Image size 2352x1568 — 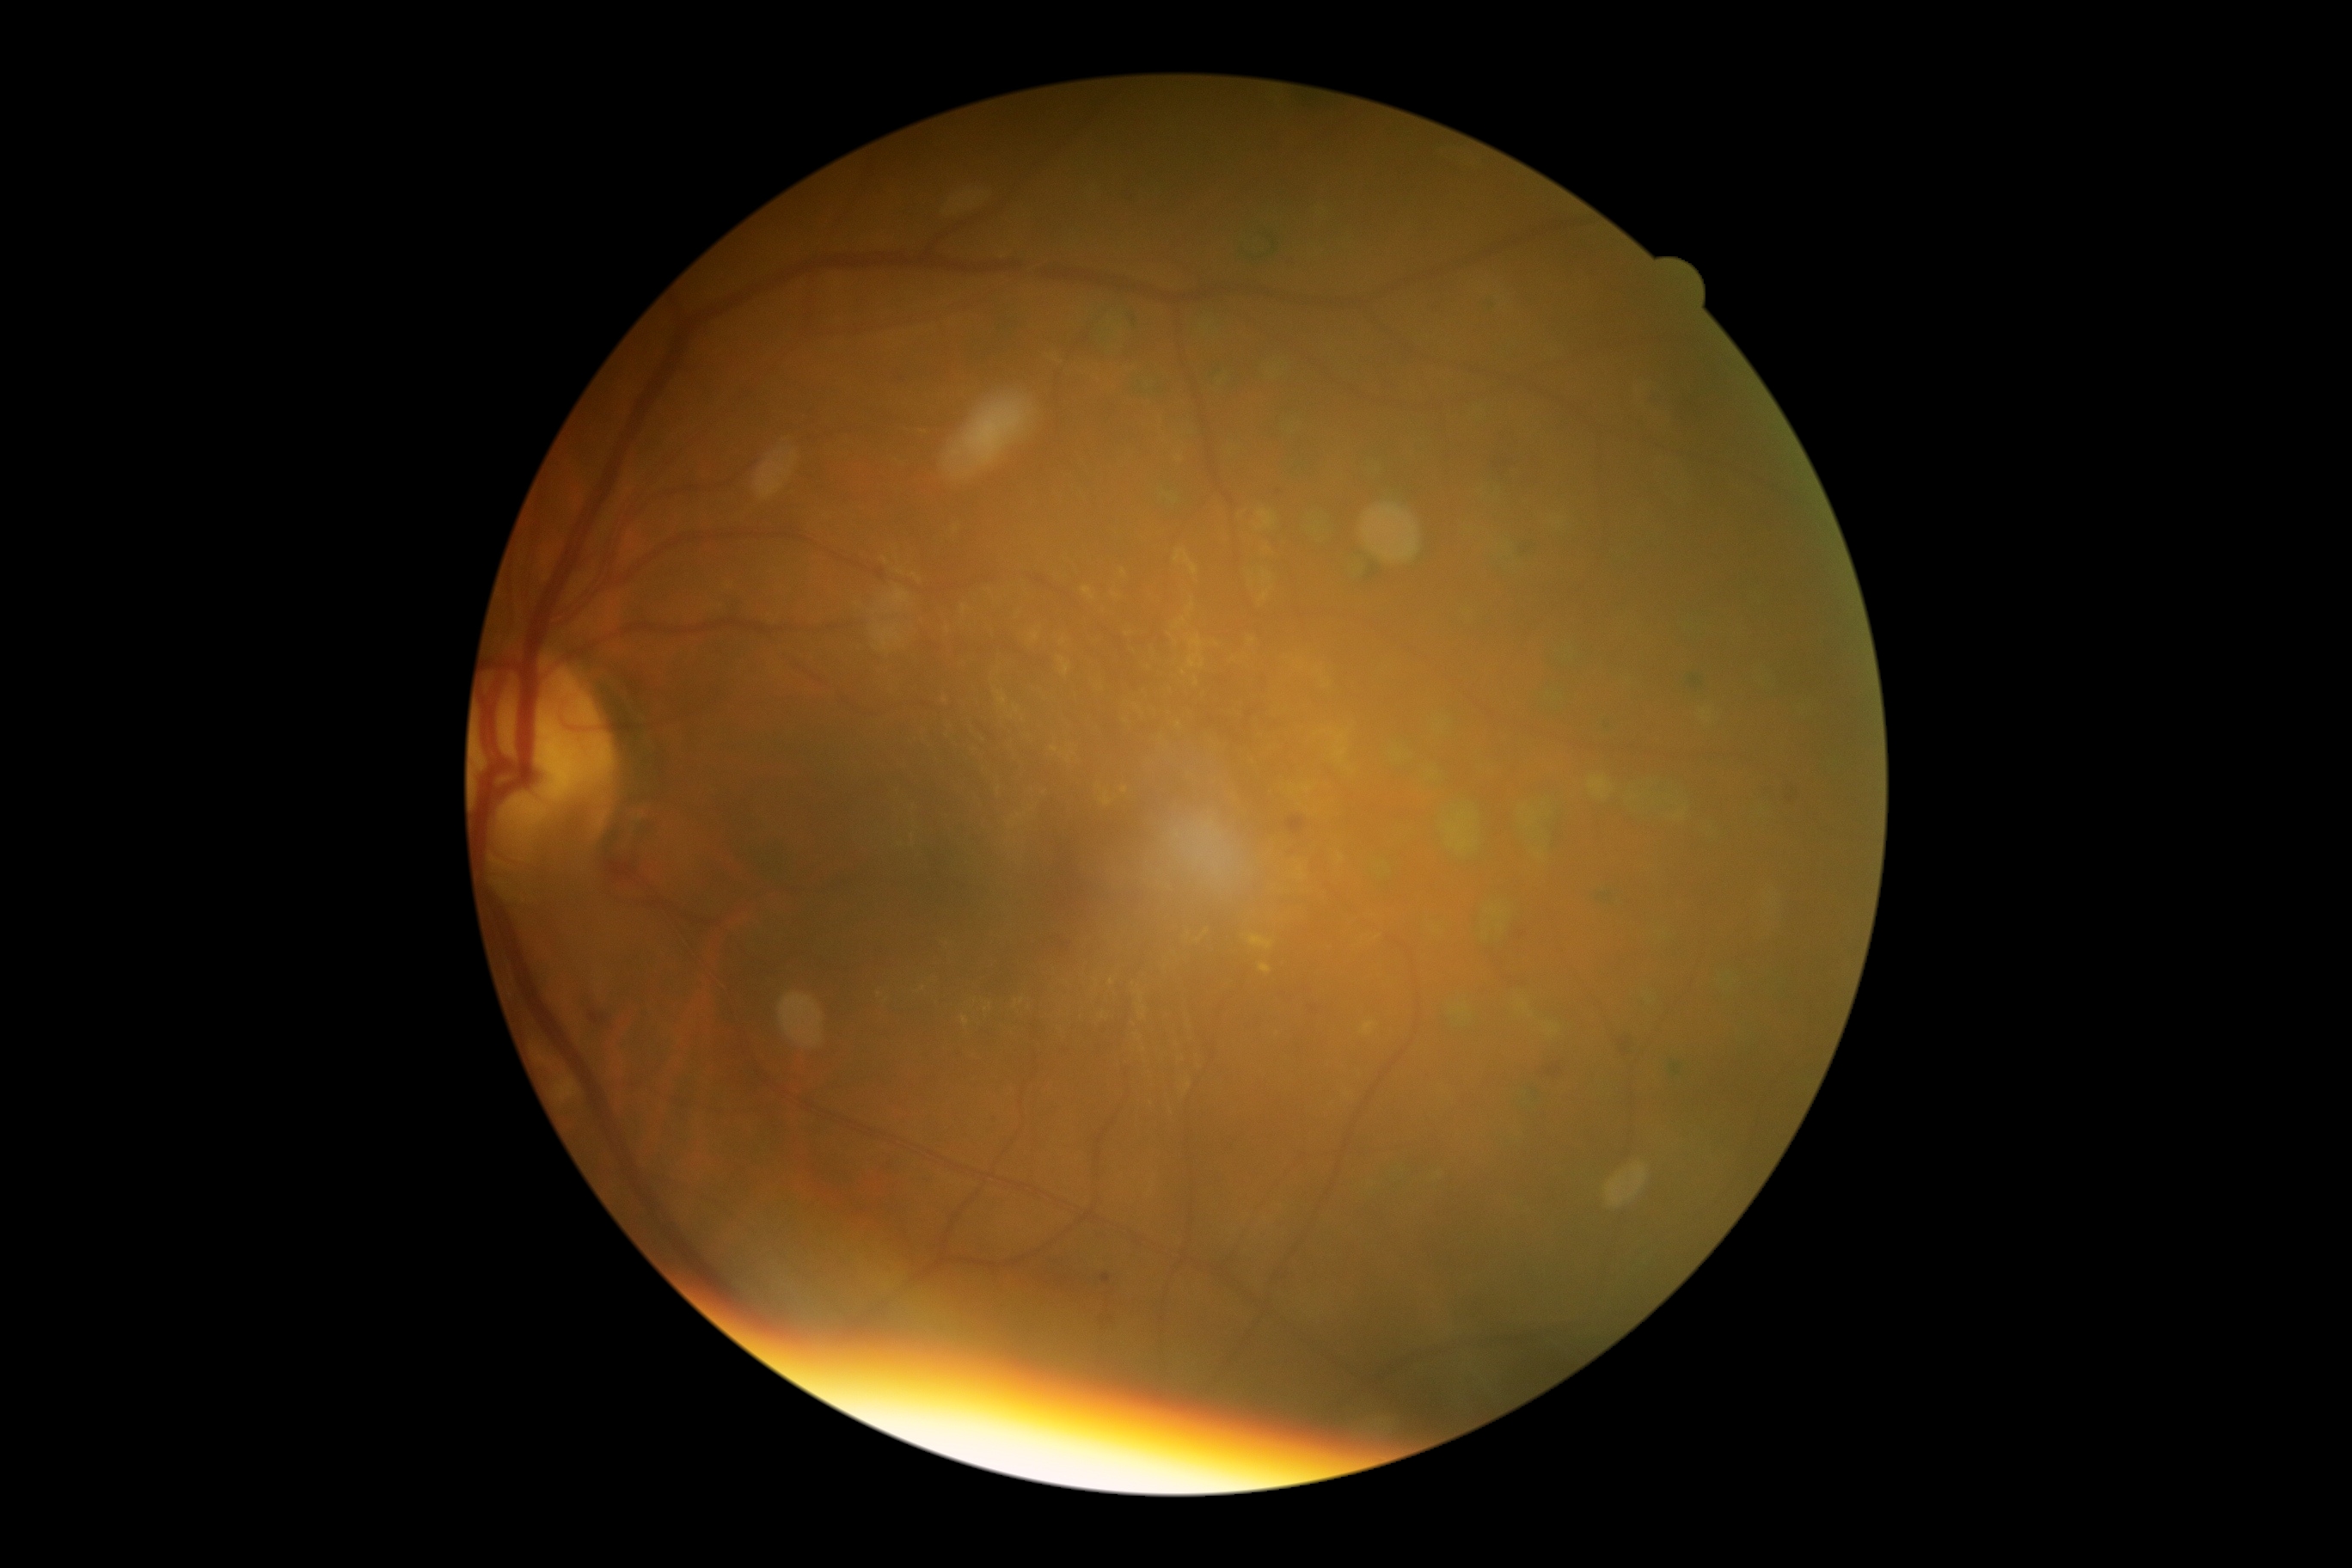
The retinopathy is classified as non-proliferative diabetic retinopathy.
Diabetic retinopathy (DR) is 2.